Fundus photo: 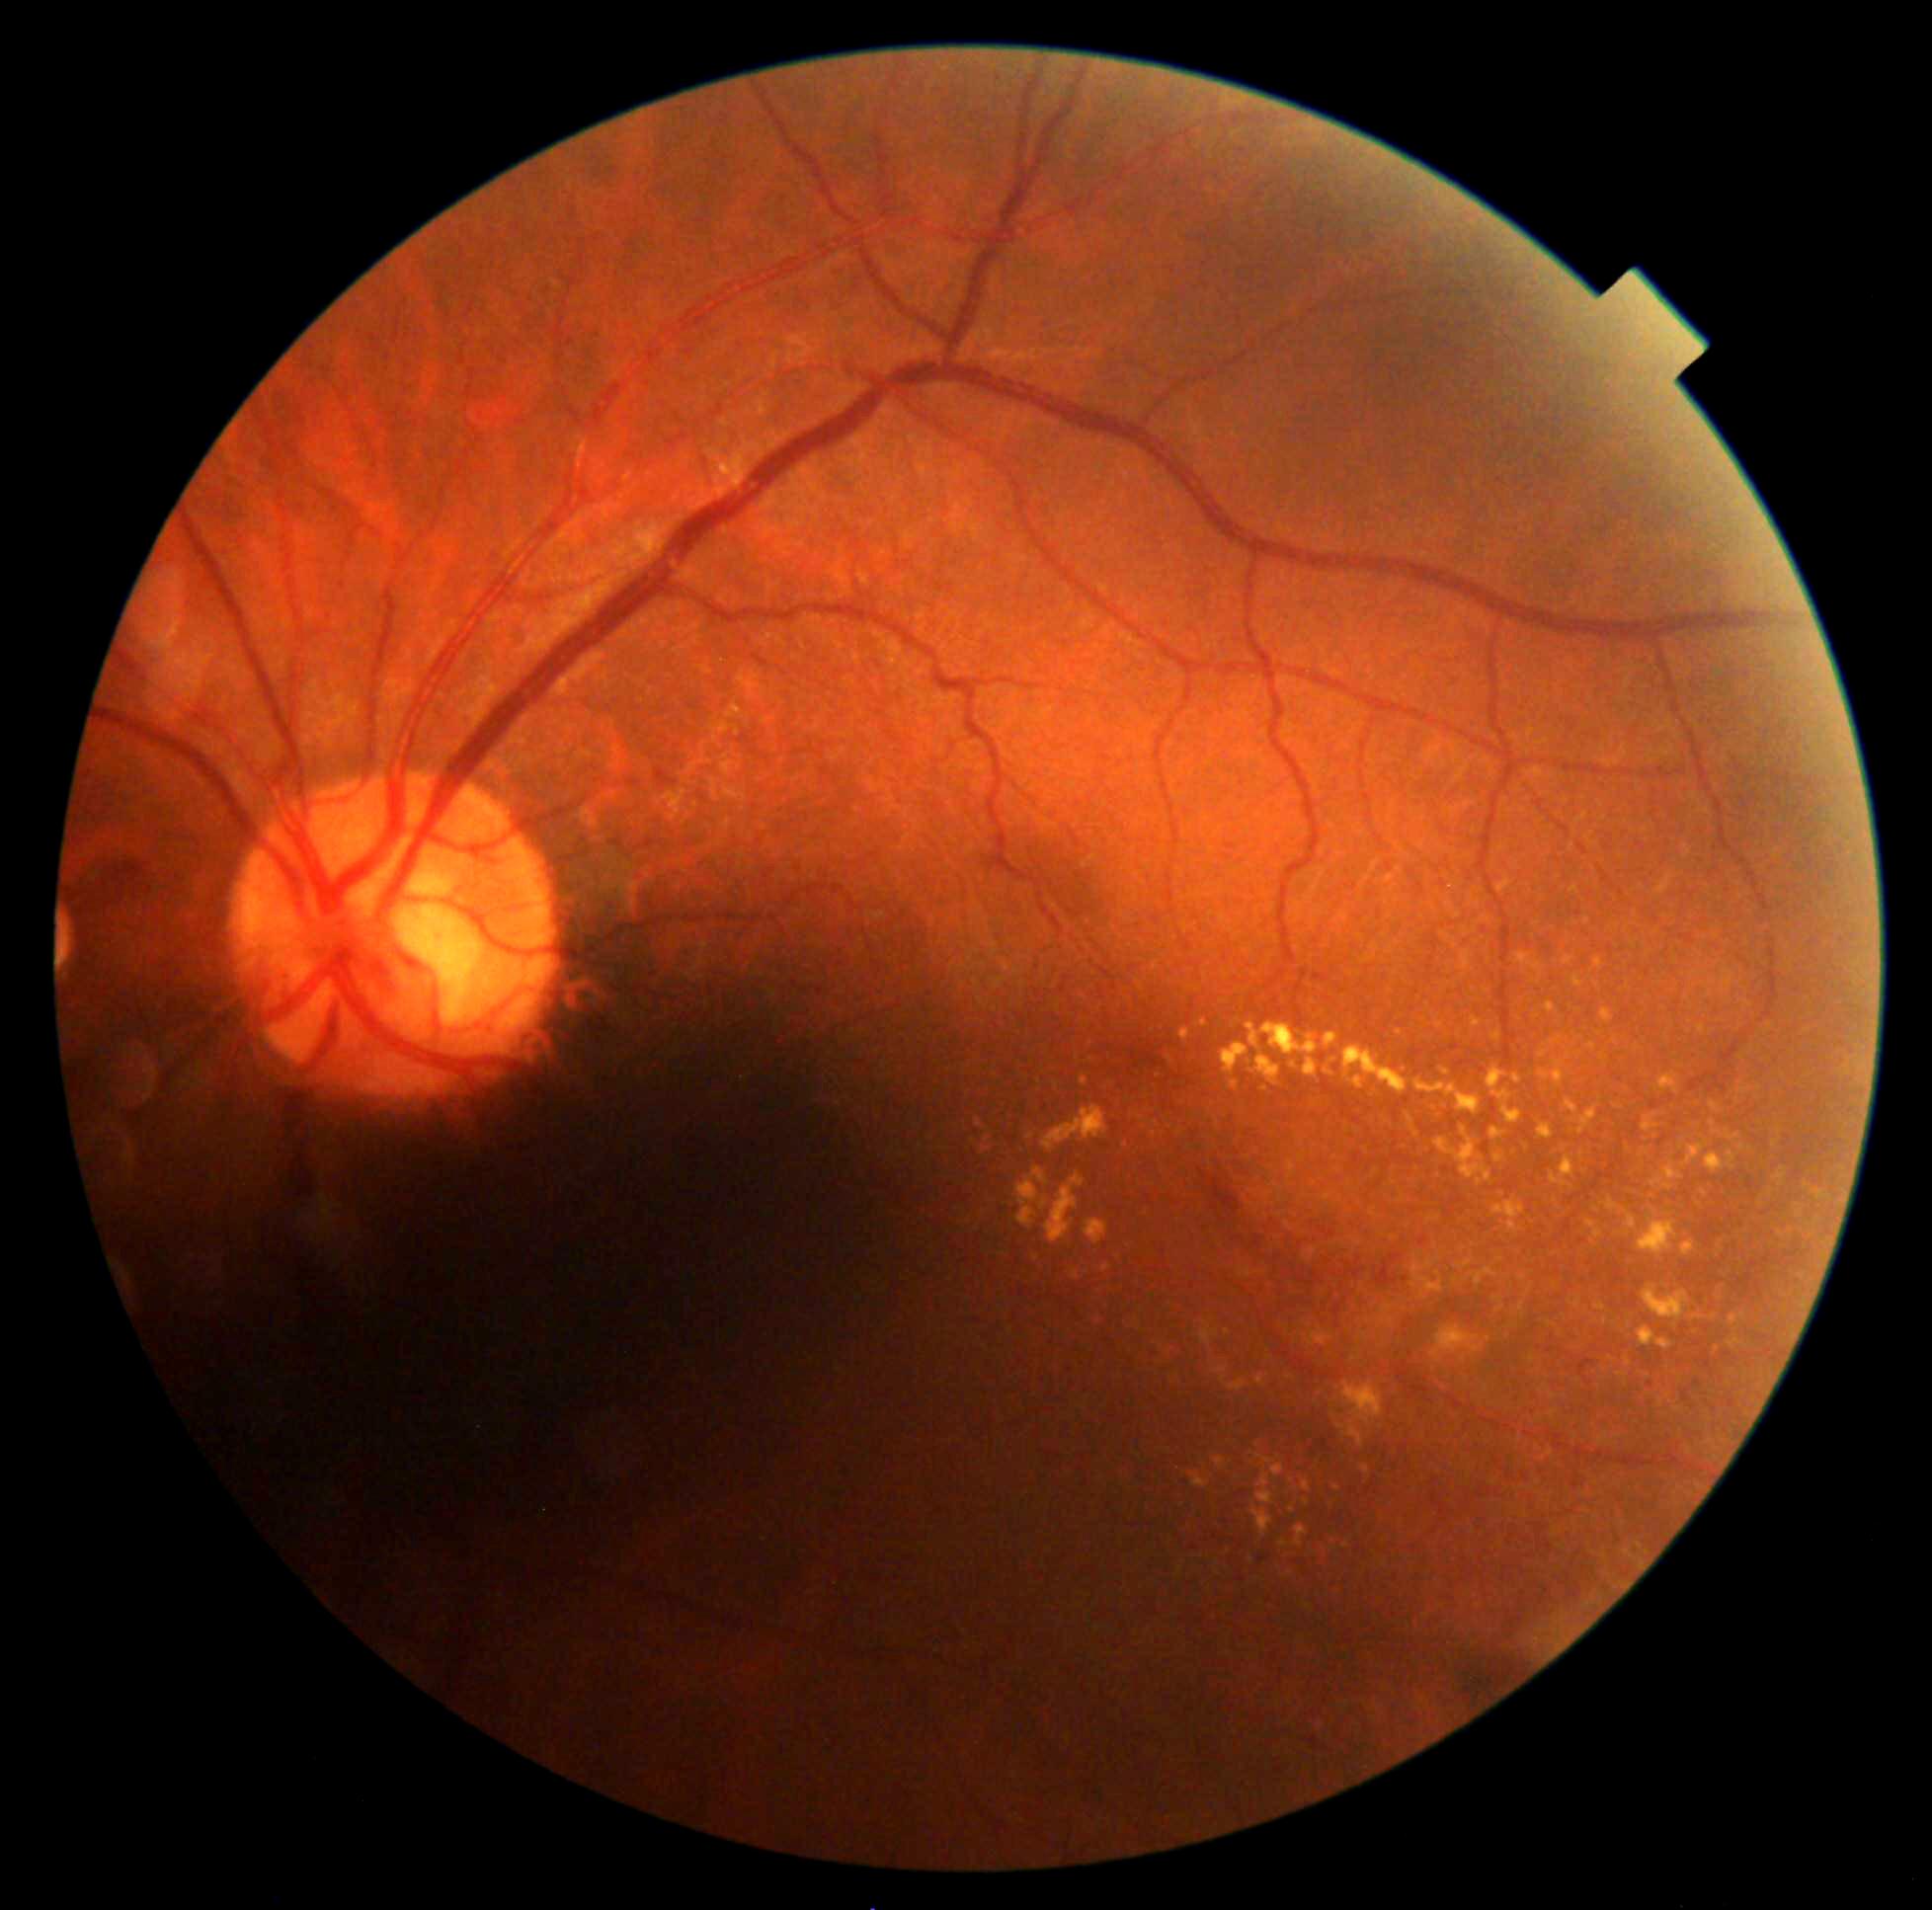 <lesions partial="true">
  <dr_grade>2</dr_grade>
  <ex partial="true">1257, 1456, 1275, 1466; 1605, 1198, 1621, 1213; 1683, 845, 1692, 859; 1434, 1127, 1491, 1184; 1305, 1323, 1313, 1328; 1436, 1021, 1445, 1030; 1639, 1218, 1680, 1259; 1361, 1465, 1370, 1475; 1190, 1474, 1210, 1490; 1705, 1152, 1737, 1174; 1102, 1266, 1112, 1273; 1304, 1327, 1334, 1347; 1289, 1506, 1296, 1514</ex>
  <ex_small_approx>pt(1615, 1042); pt(1776, 1144); pt(1759, 1089); pt(1078, 1058); pt(1037, 1259); pt(1480, 1183)</ex_small_approx>
</lesions>